Optic disc region of a color fundus photo — 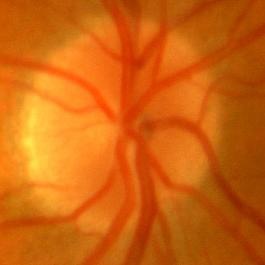
There is evidence of no signs of glaucoma.